Nonmydriatic fundus photograph, Davis DR grading
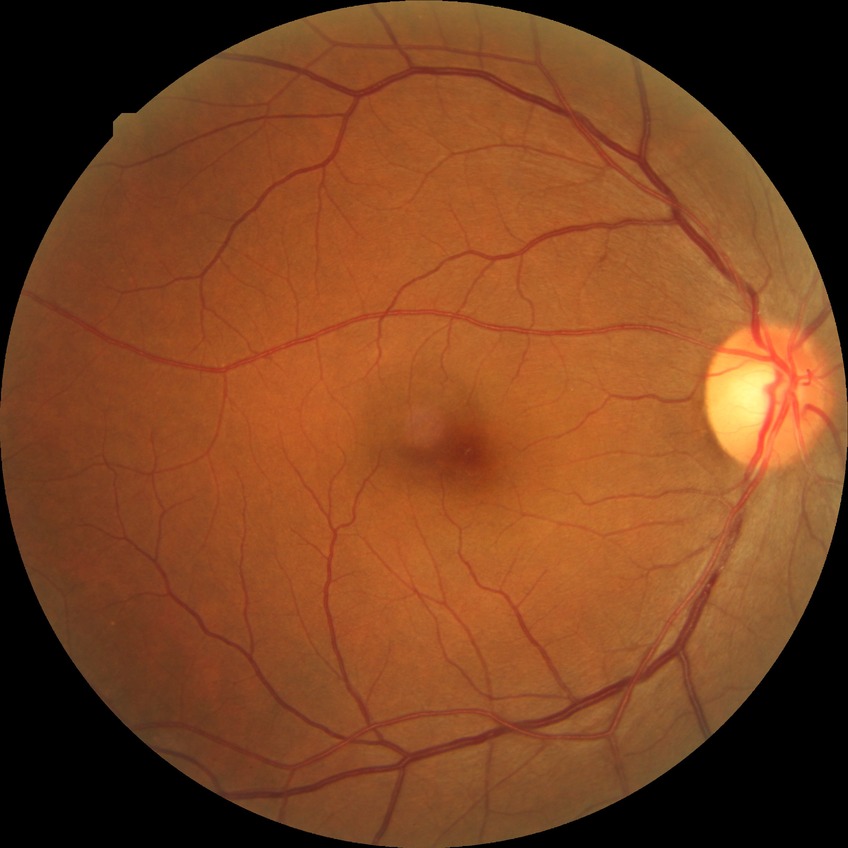

Modified Davis classification is no diabetic retinopathy.